DR severity per modified Davis staging: 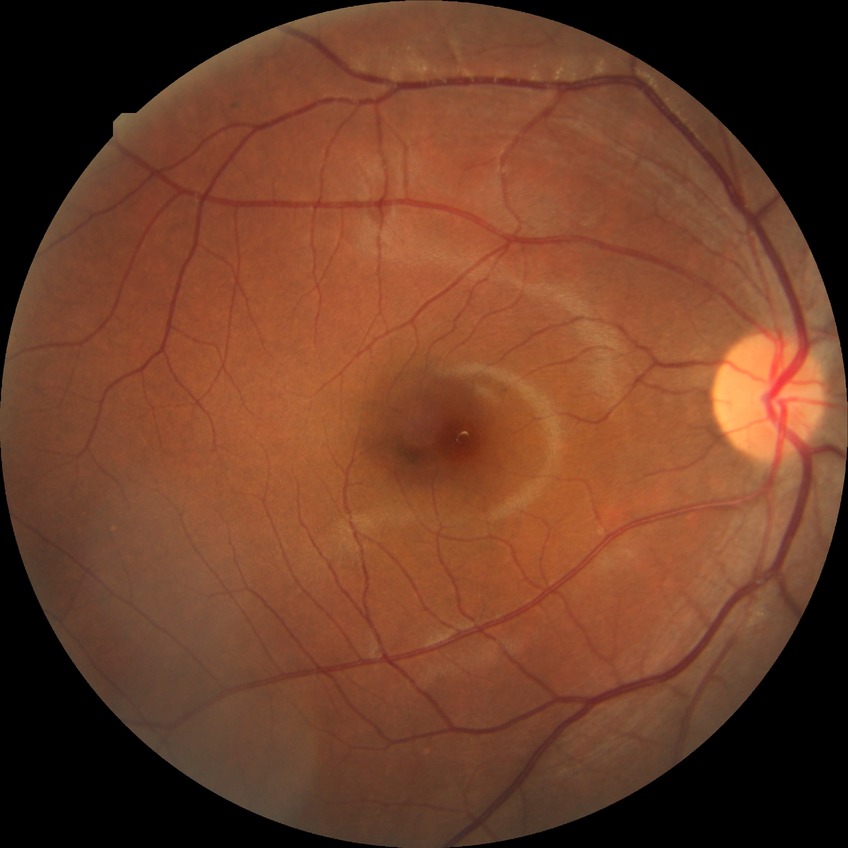

diabetic retinopathy (DR): NDR (no diabetic retinopathy)